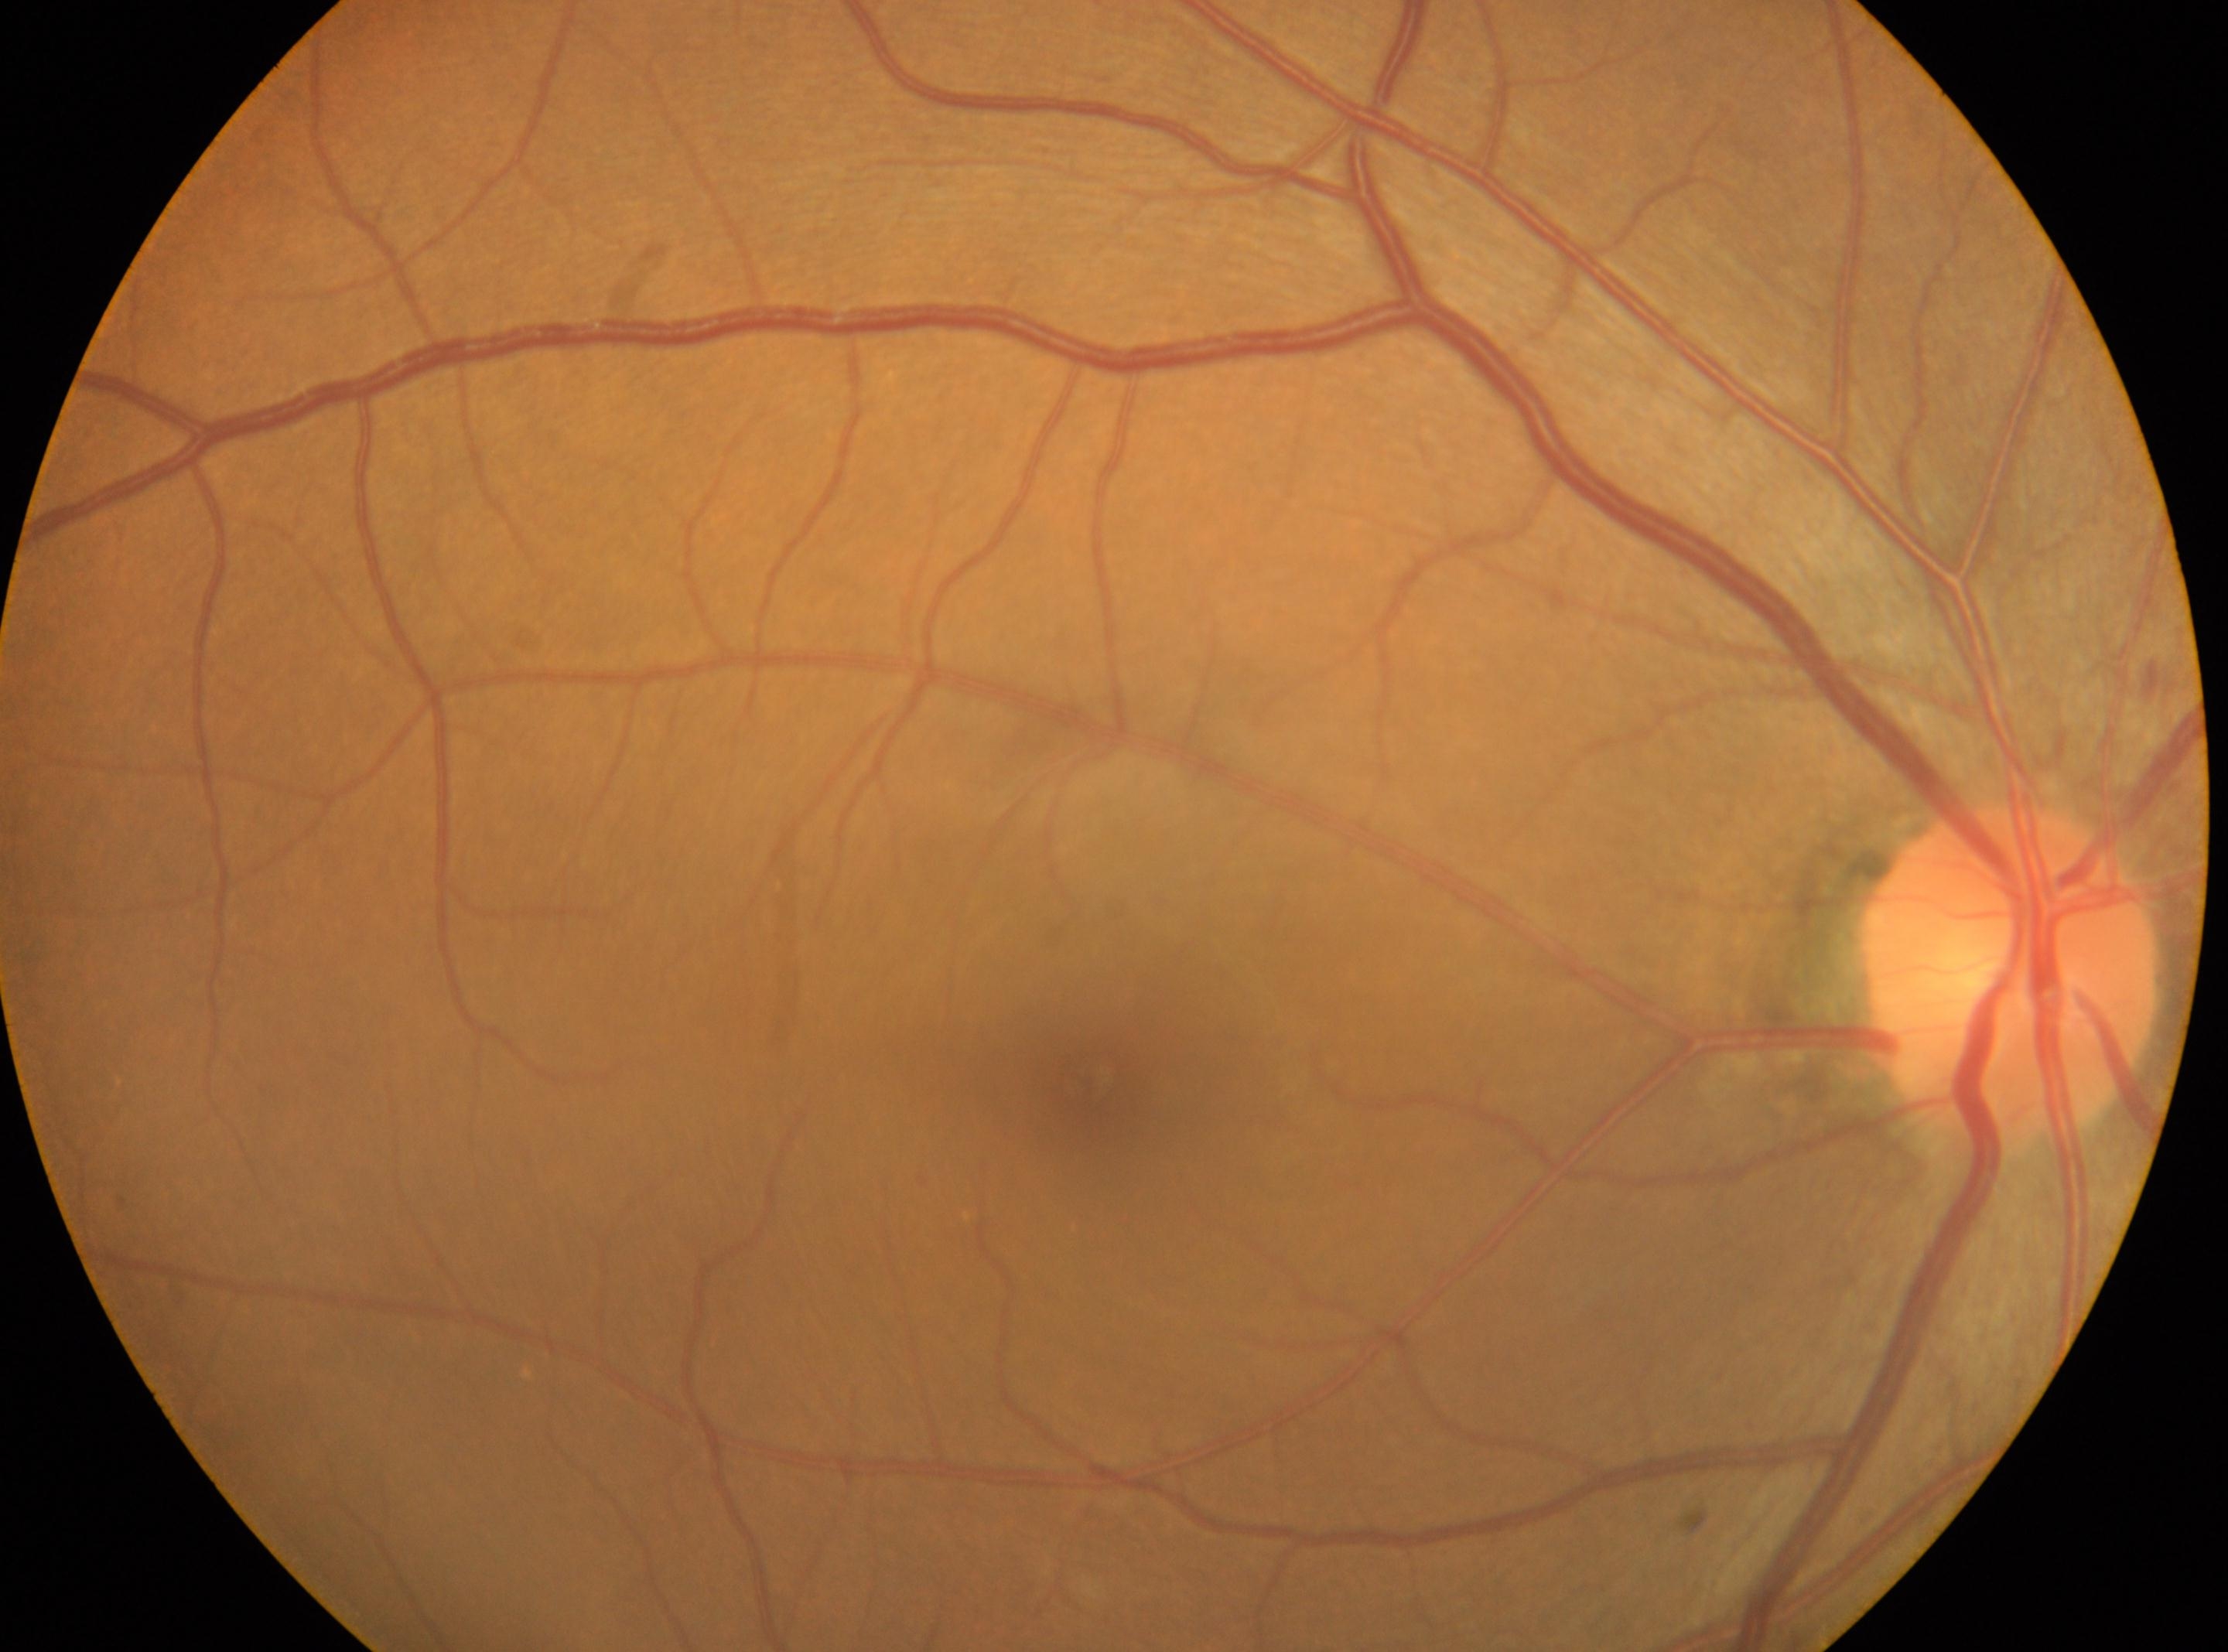

ONH = x=2011, y=974; DR grade = 0/4; laterality = oculus dexter; fovea center = x=1086, y=1081.